Pediatric wide-field fundus photograph; 1240x1240px.
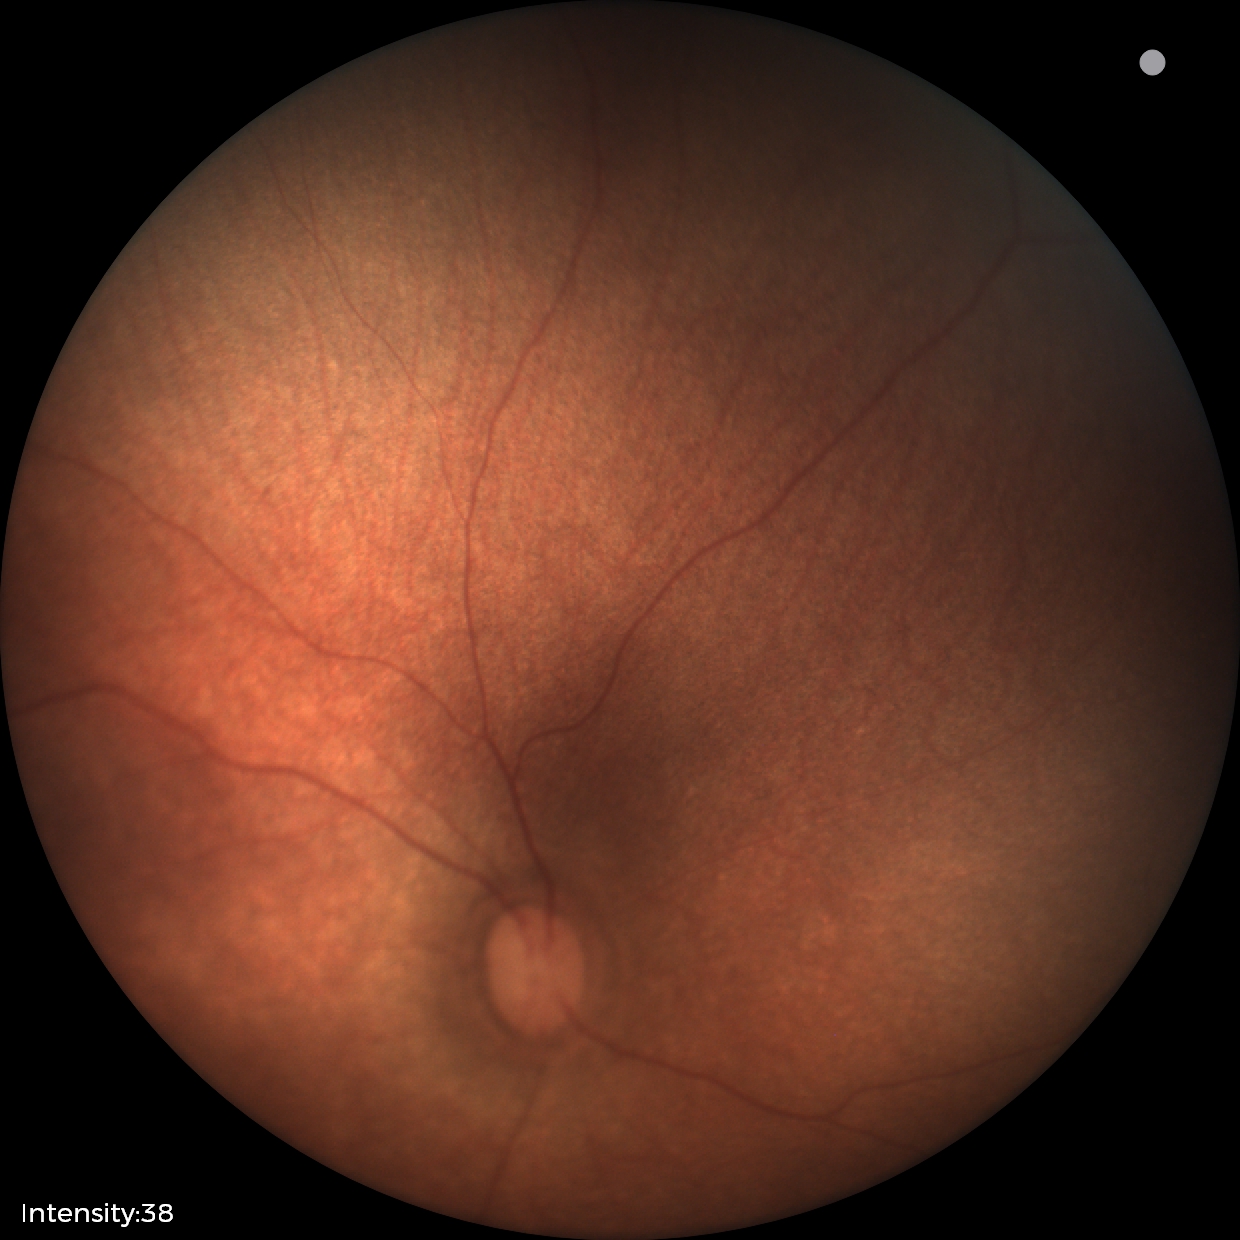 Examination with physiological retinal findings.